640 by 480 pixels; wide-field fundus image from infant ROP screening; Clarity RetCam 3, 130° FOV
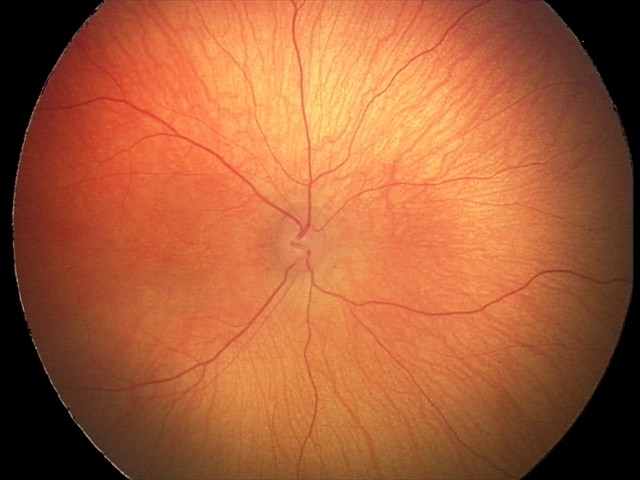 Assessment = physiological.